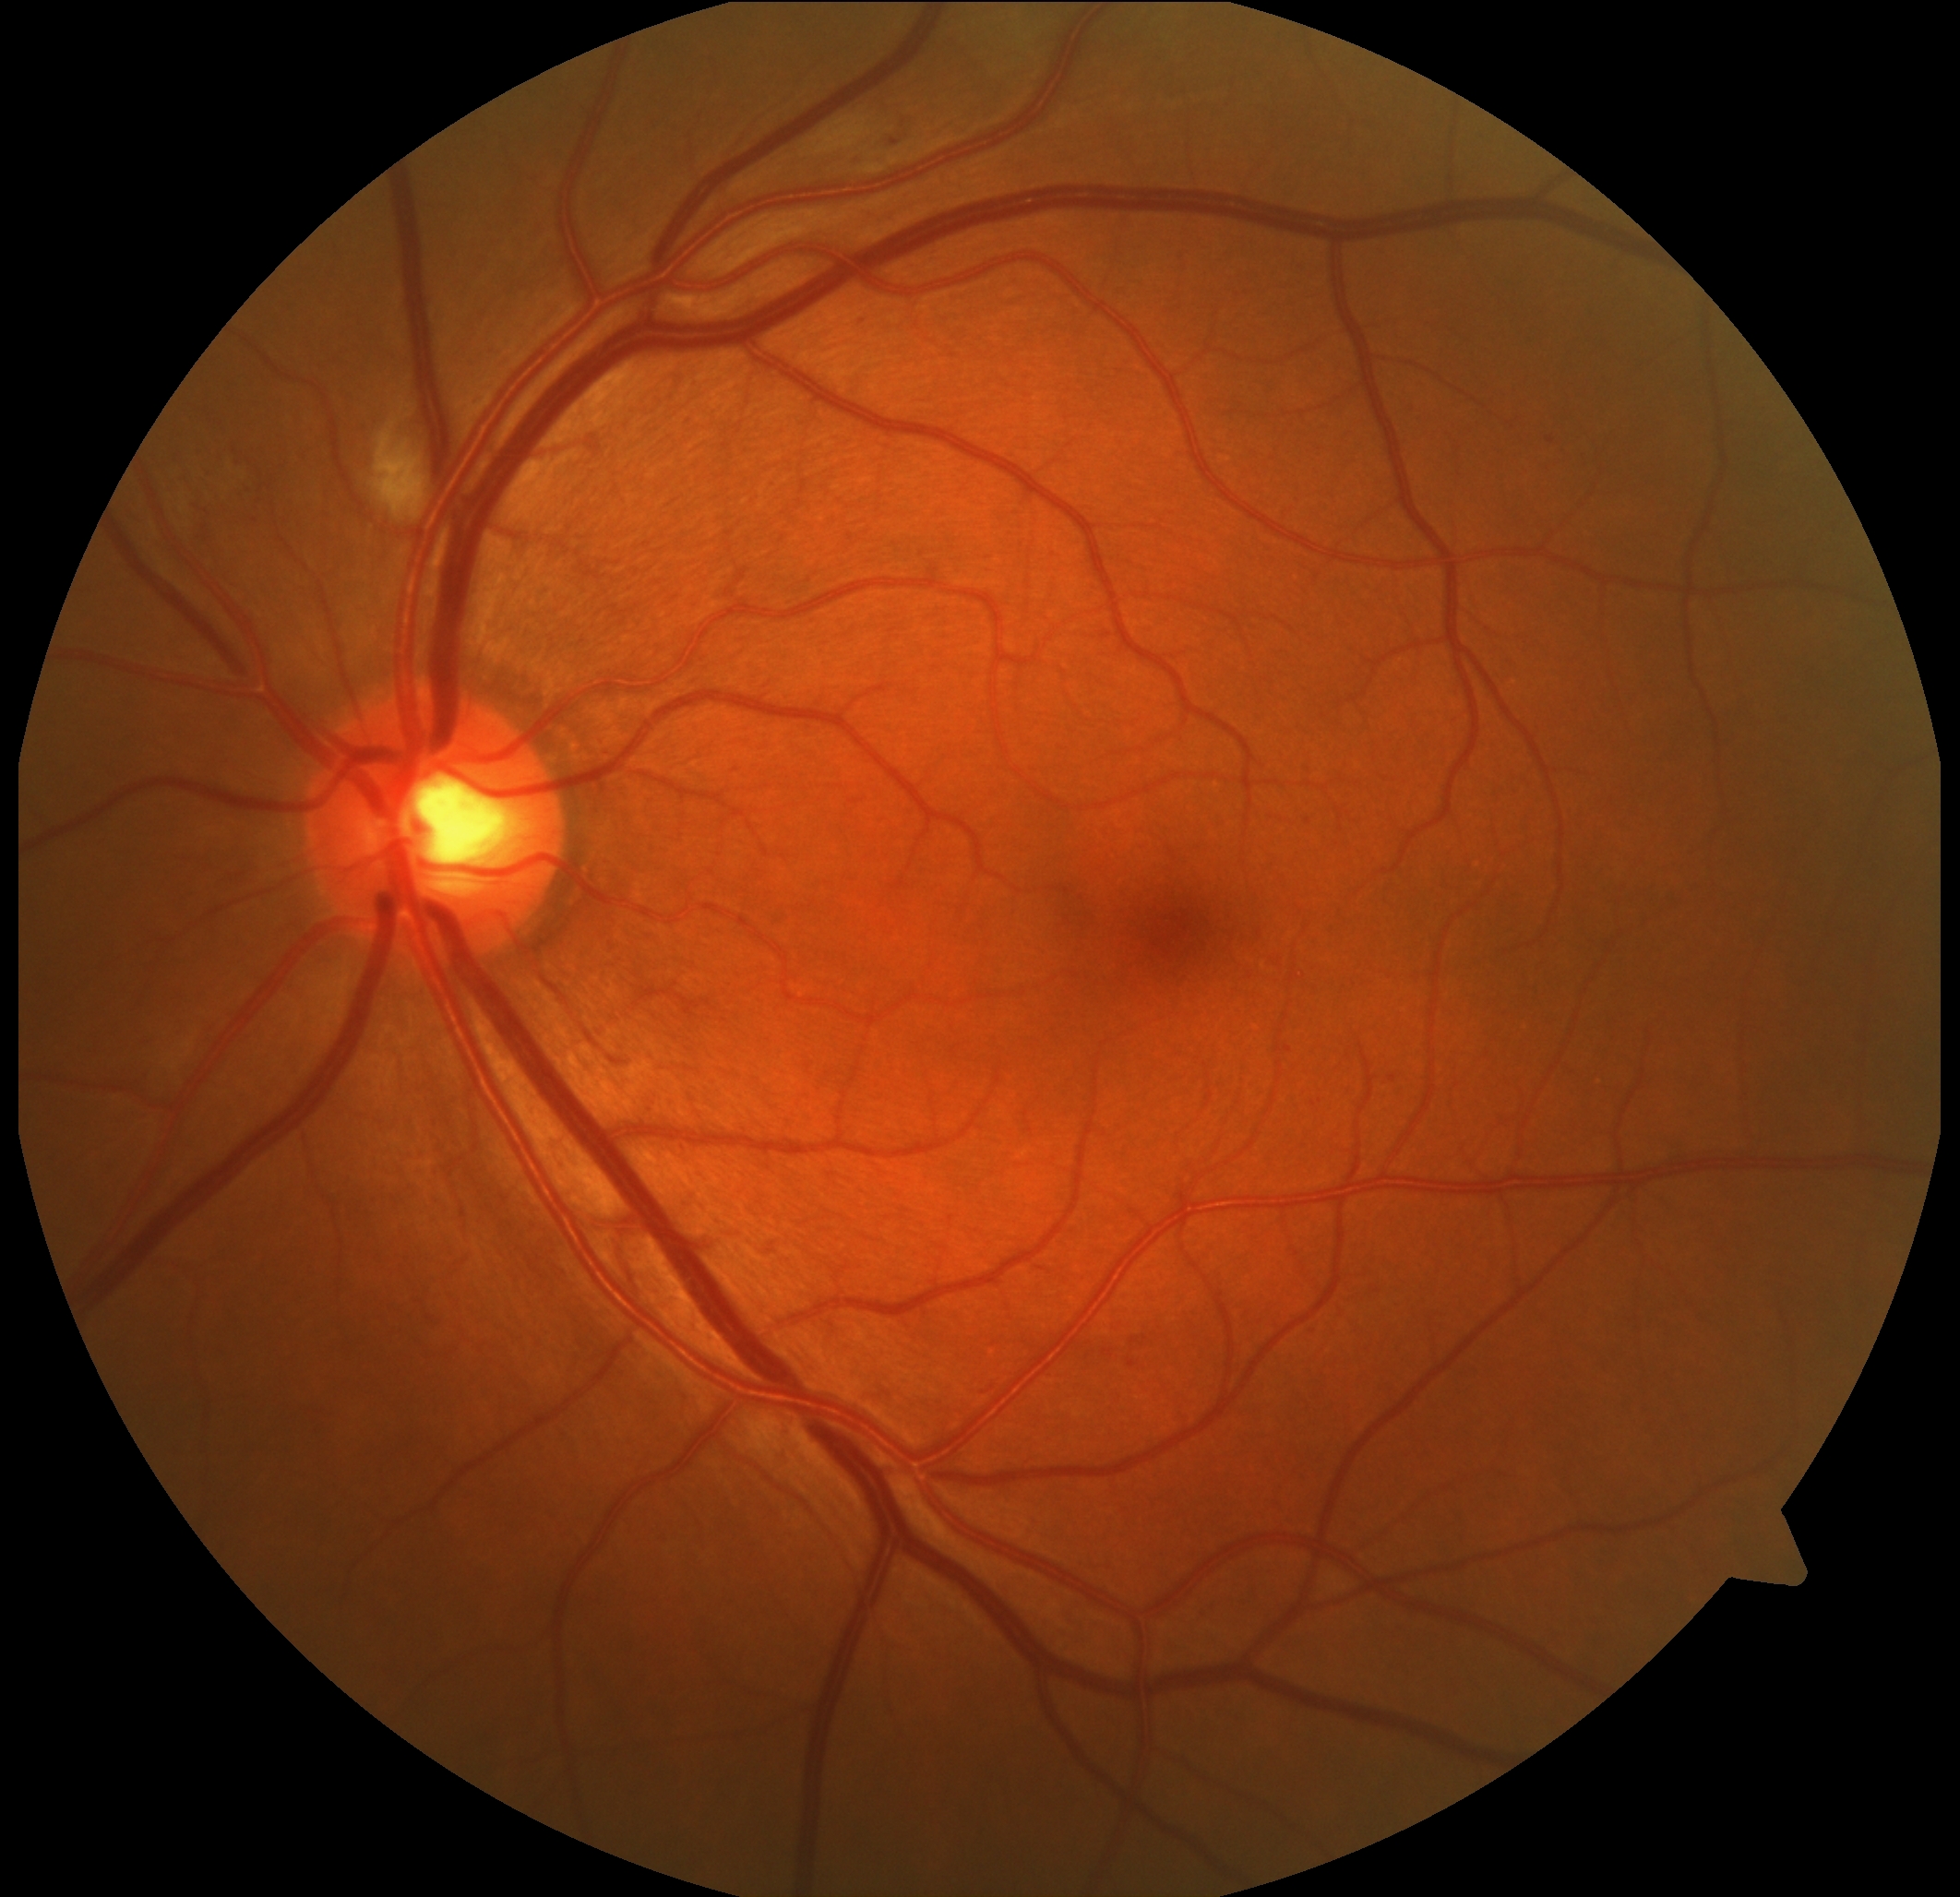 diabetic retinopathy (DR) = 2/4.